30° field of view: 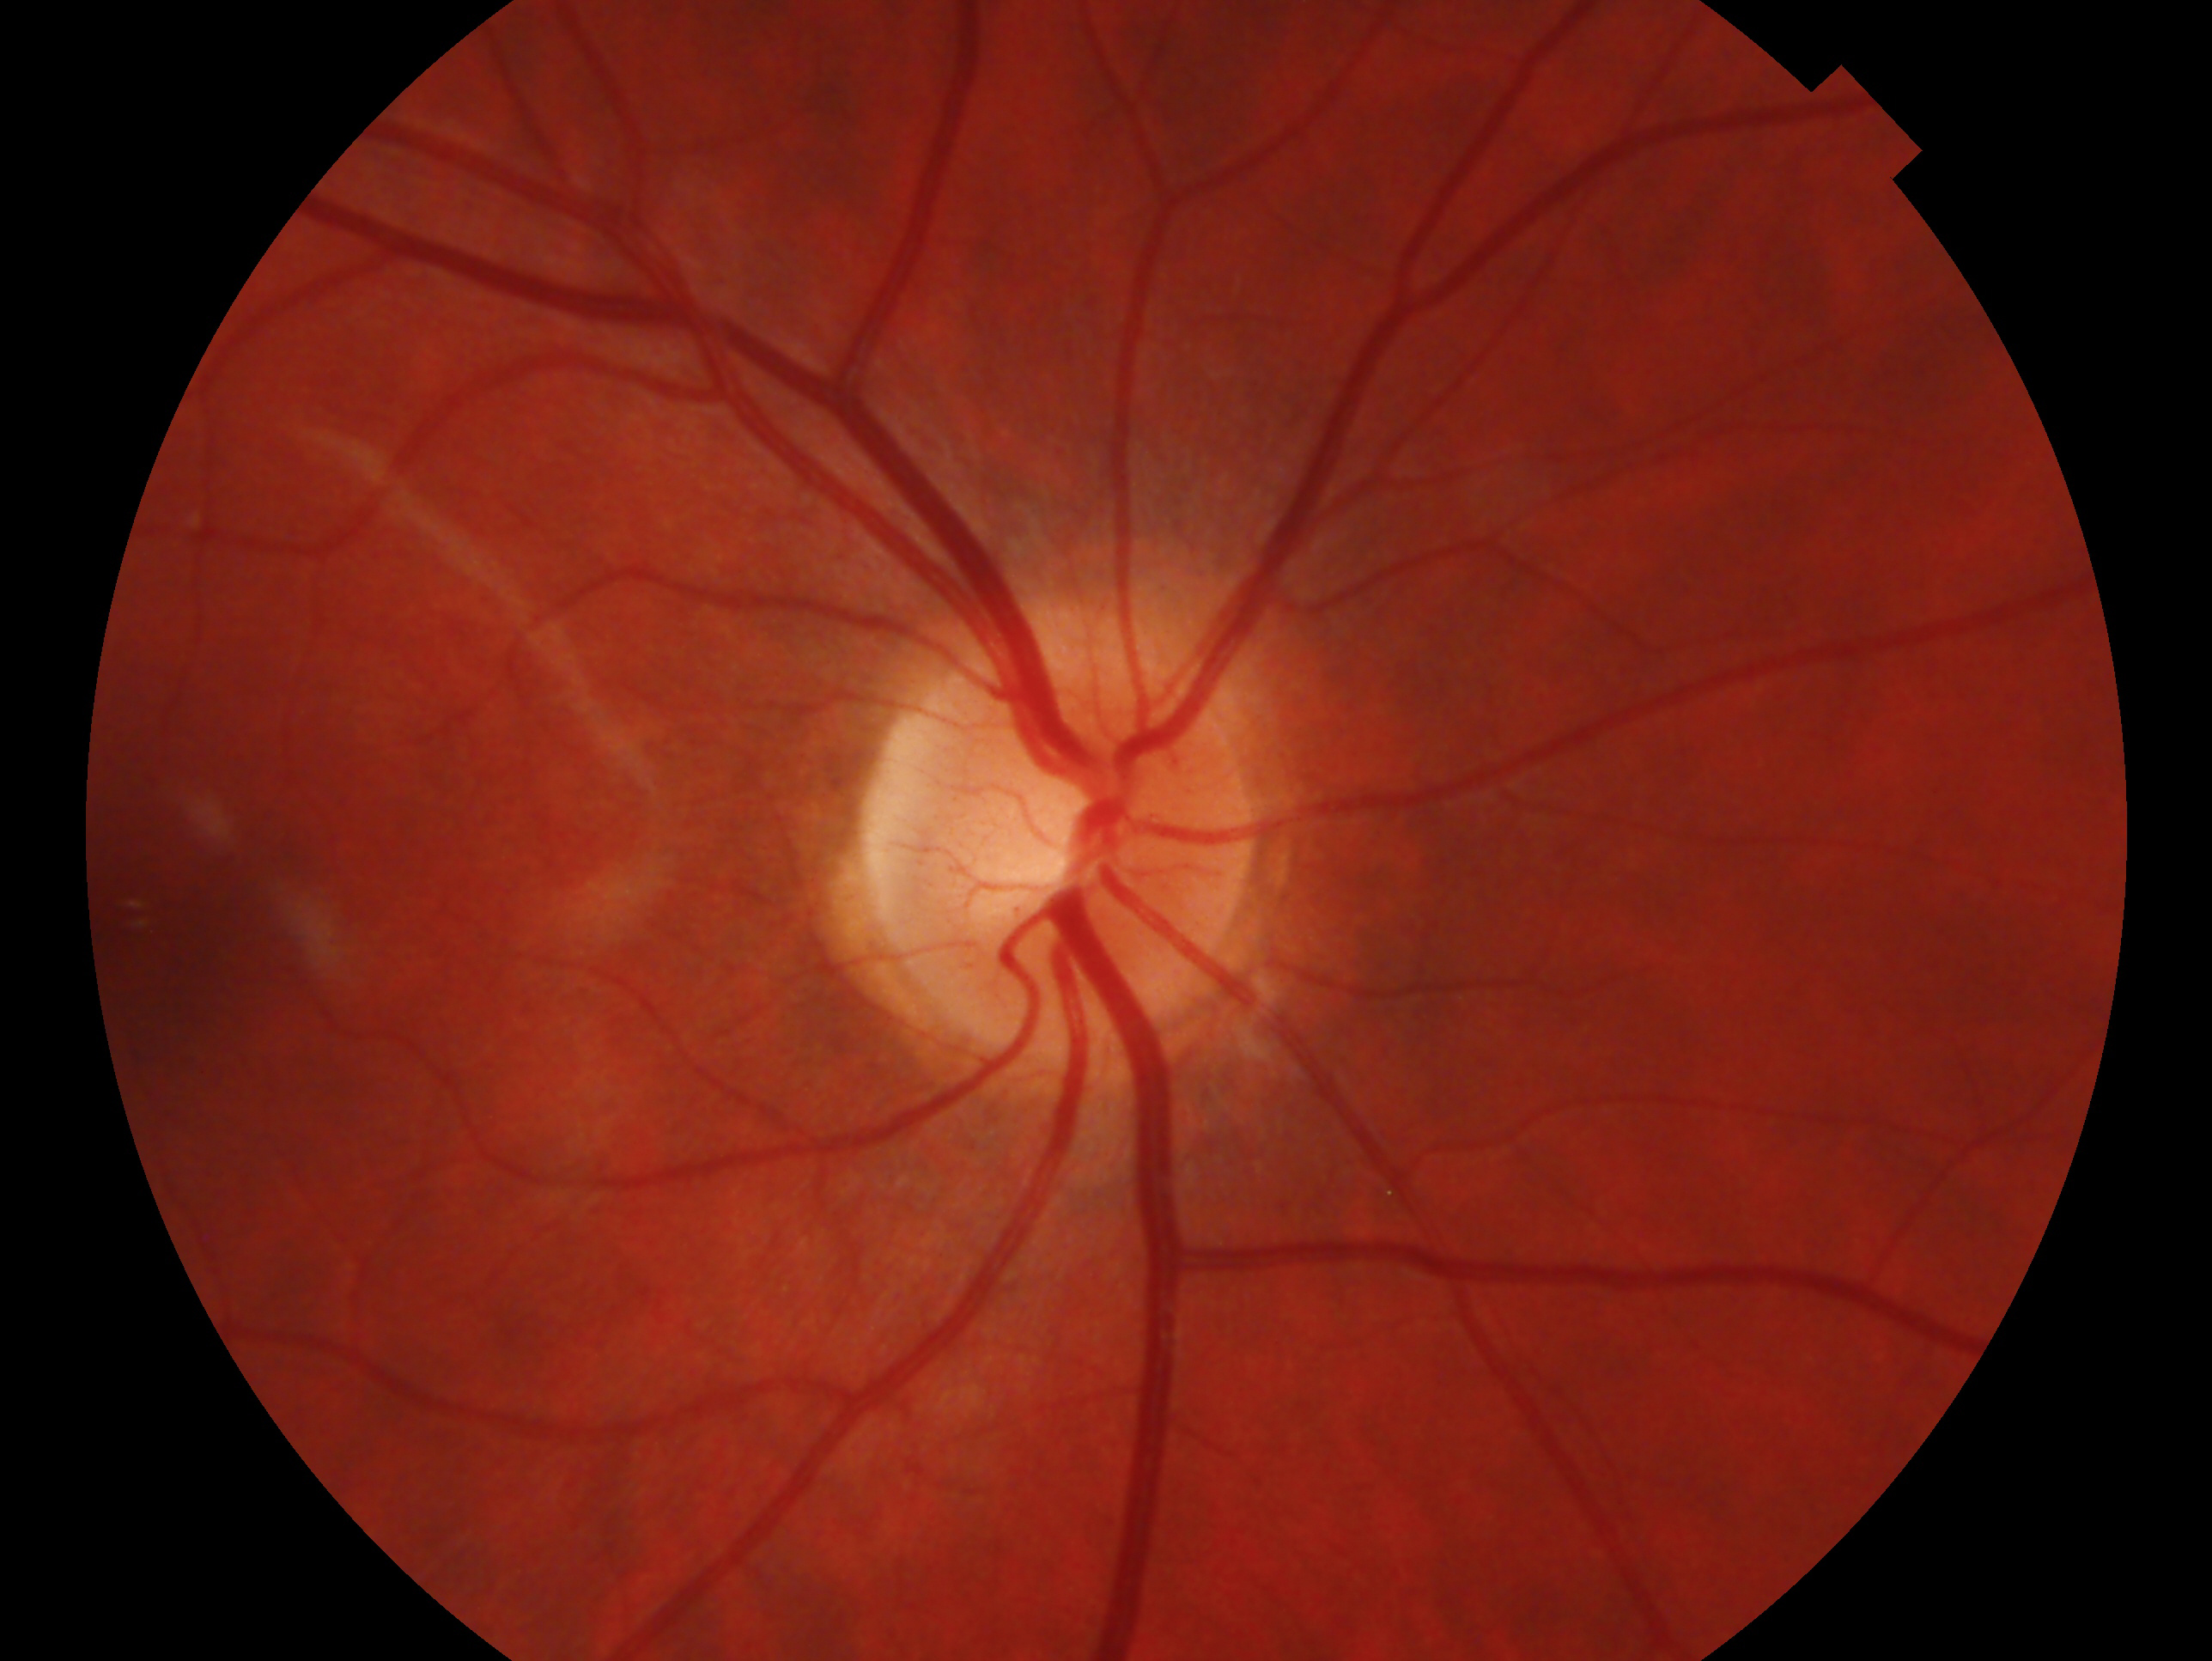

glaucoma_dx: glaucoma suspect
eye: OD